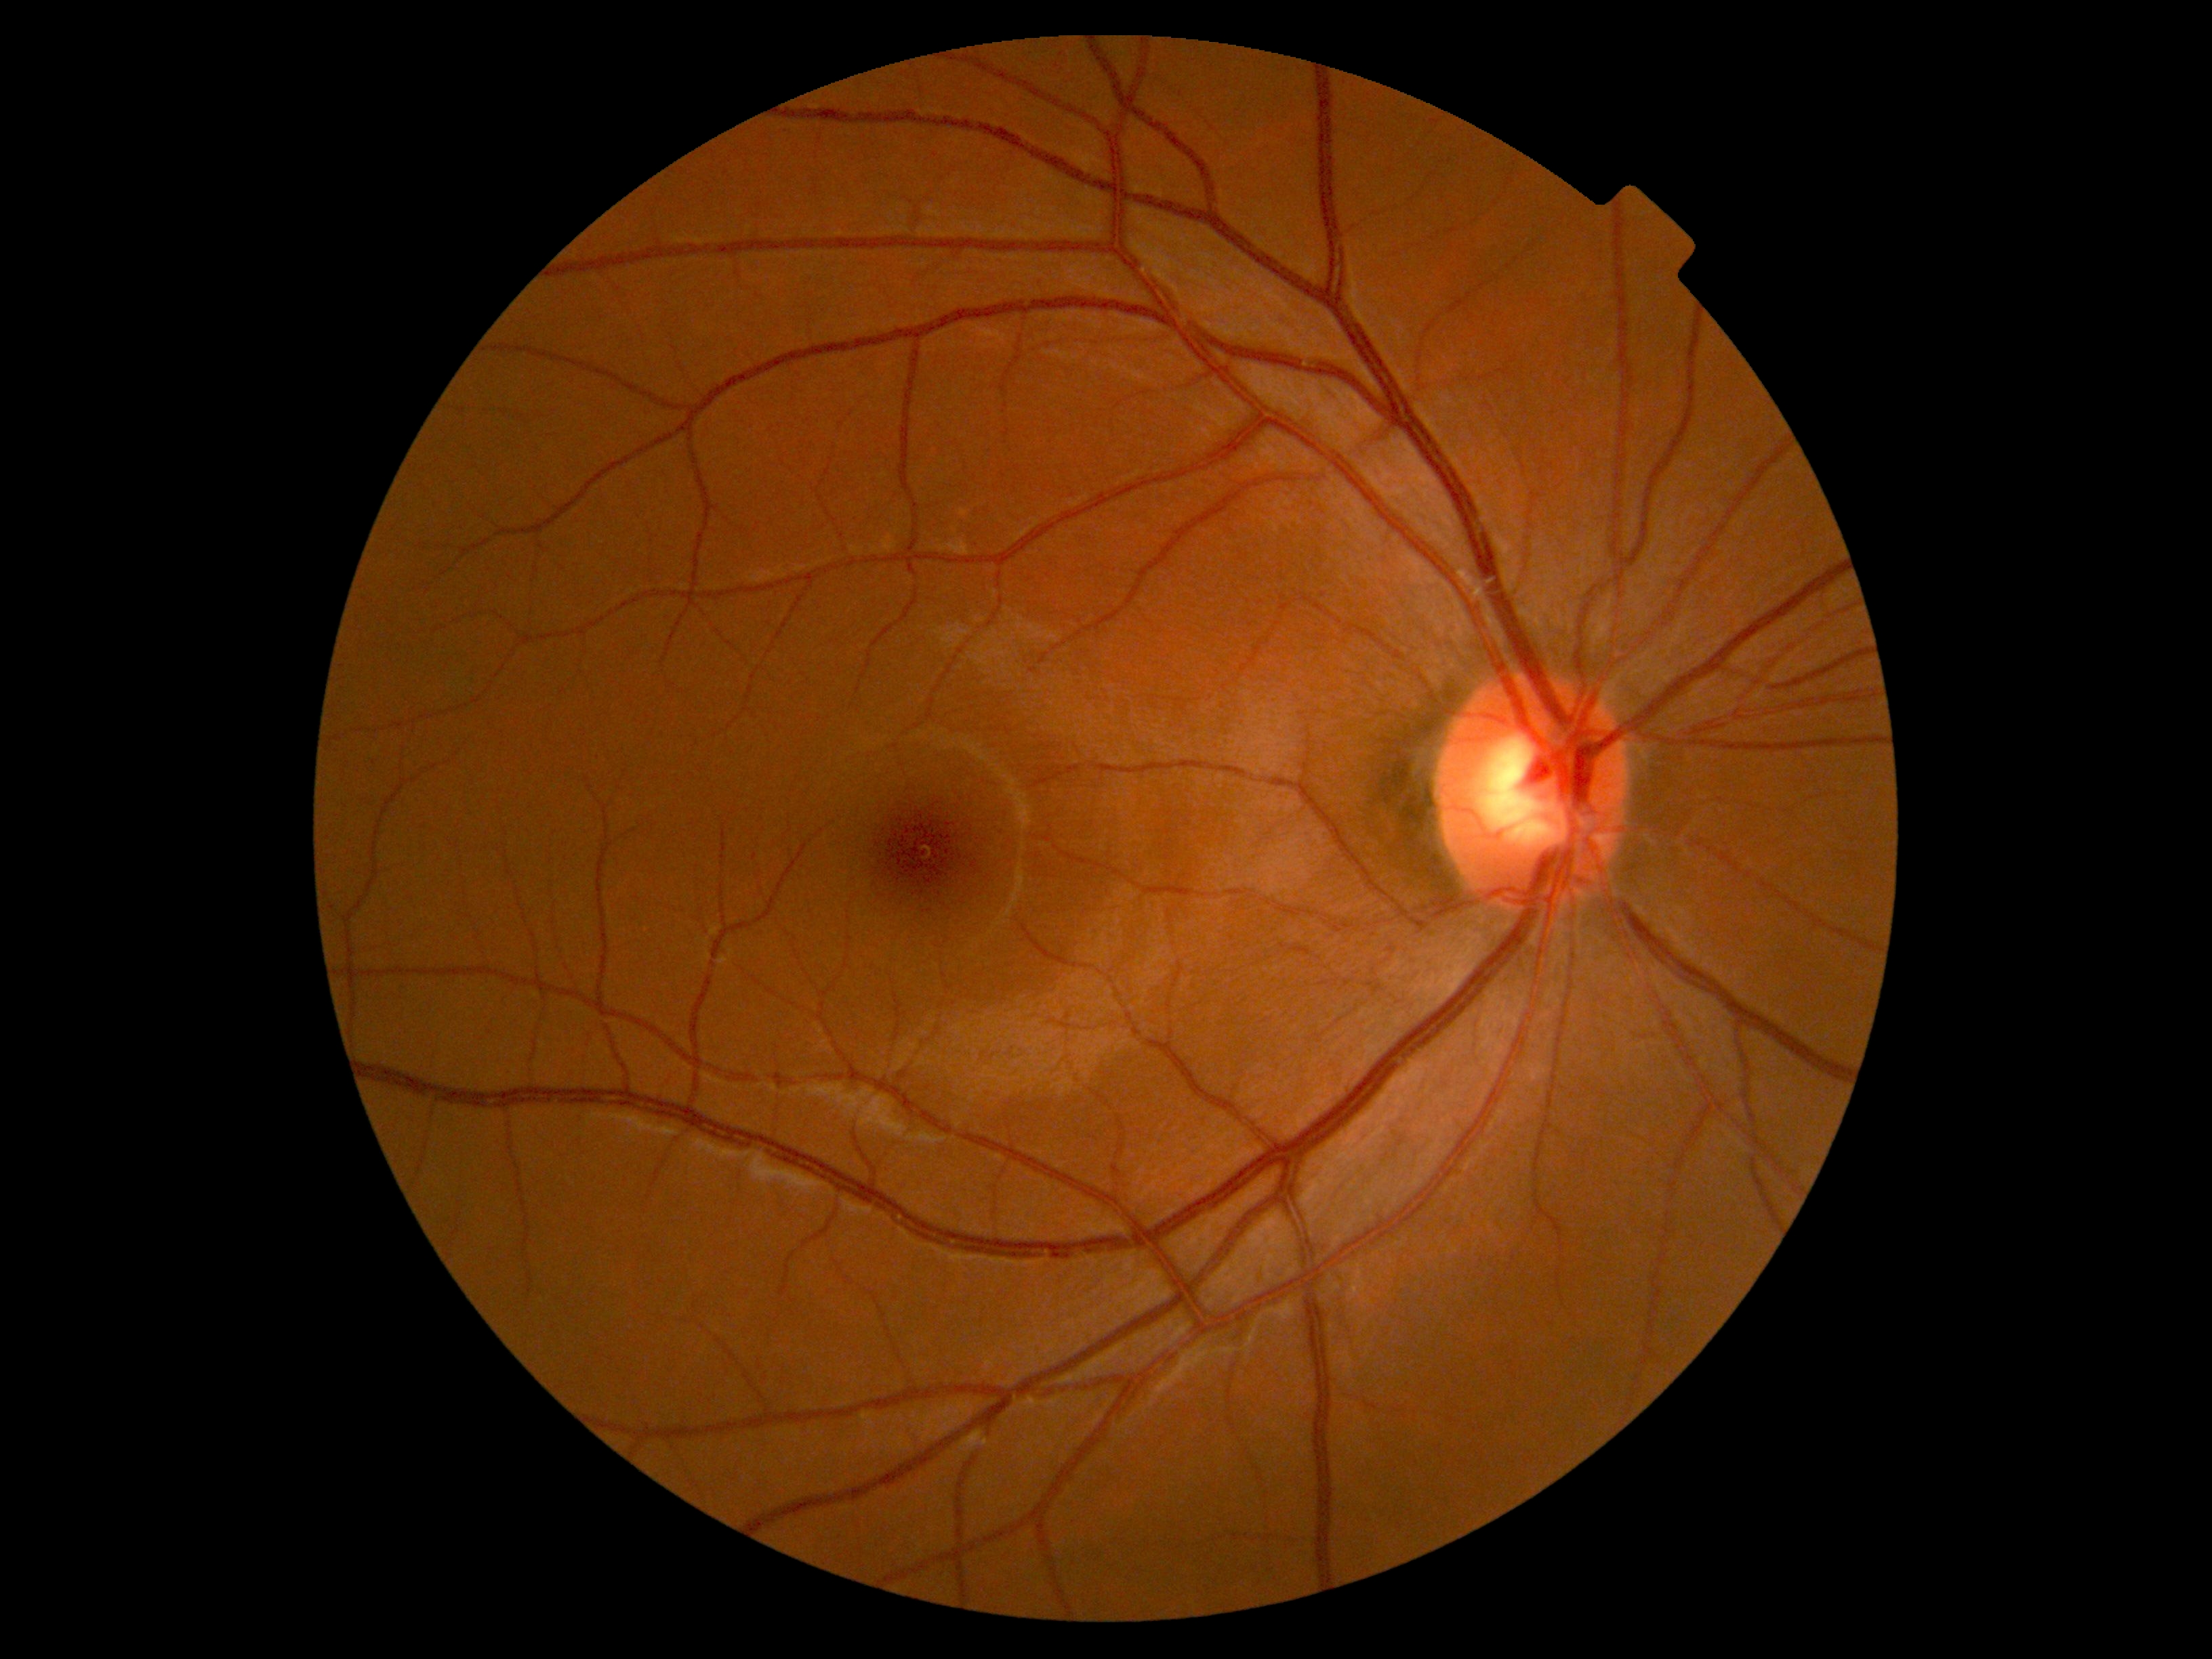

diabetic retinopathy severity: grade 0.